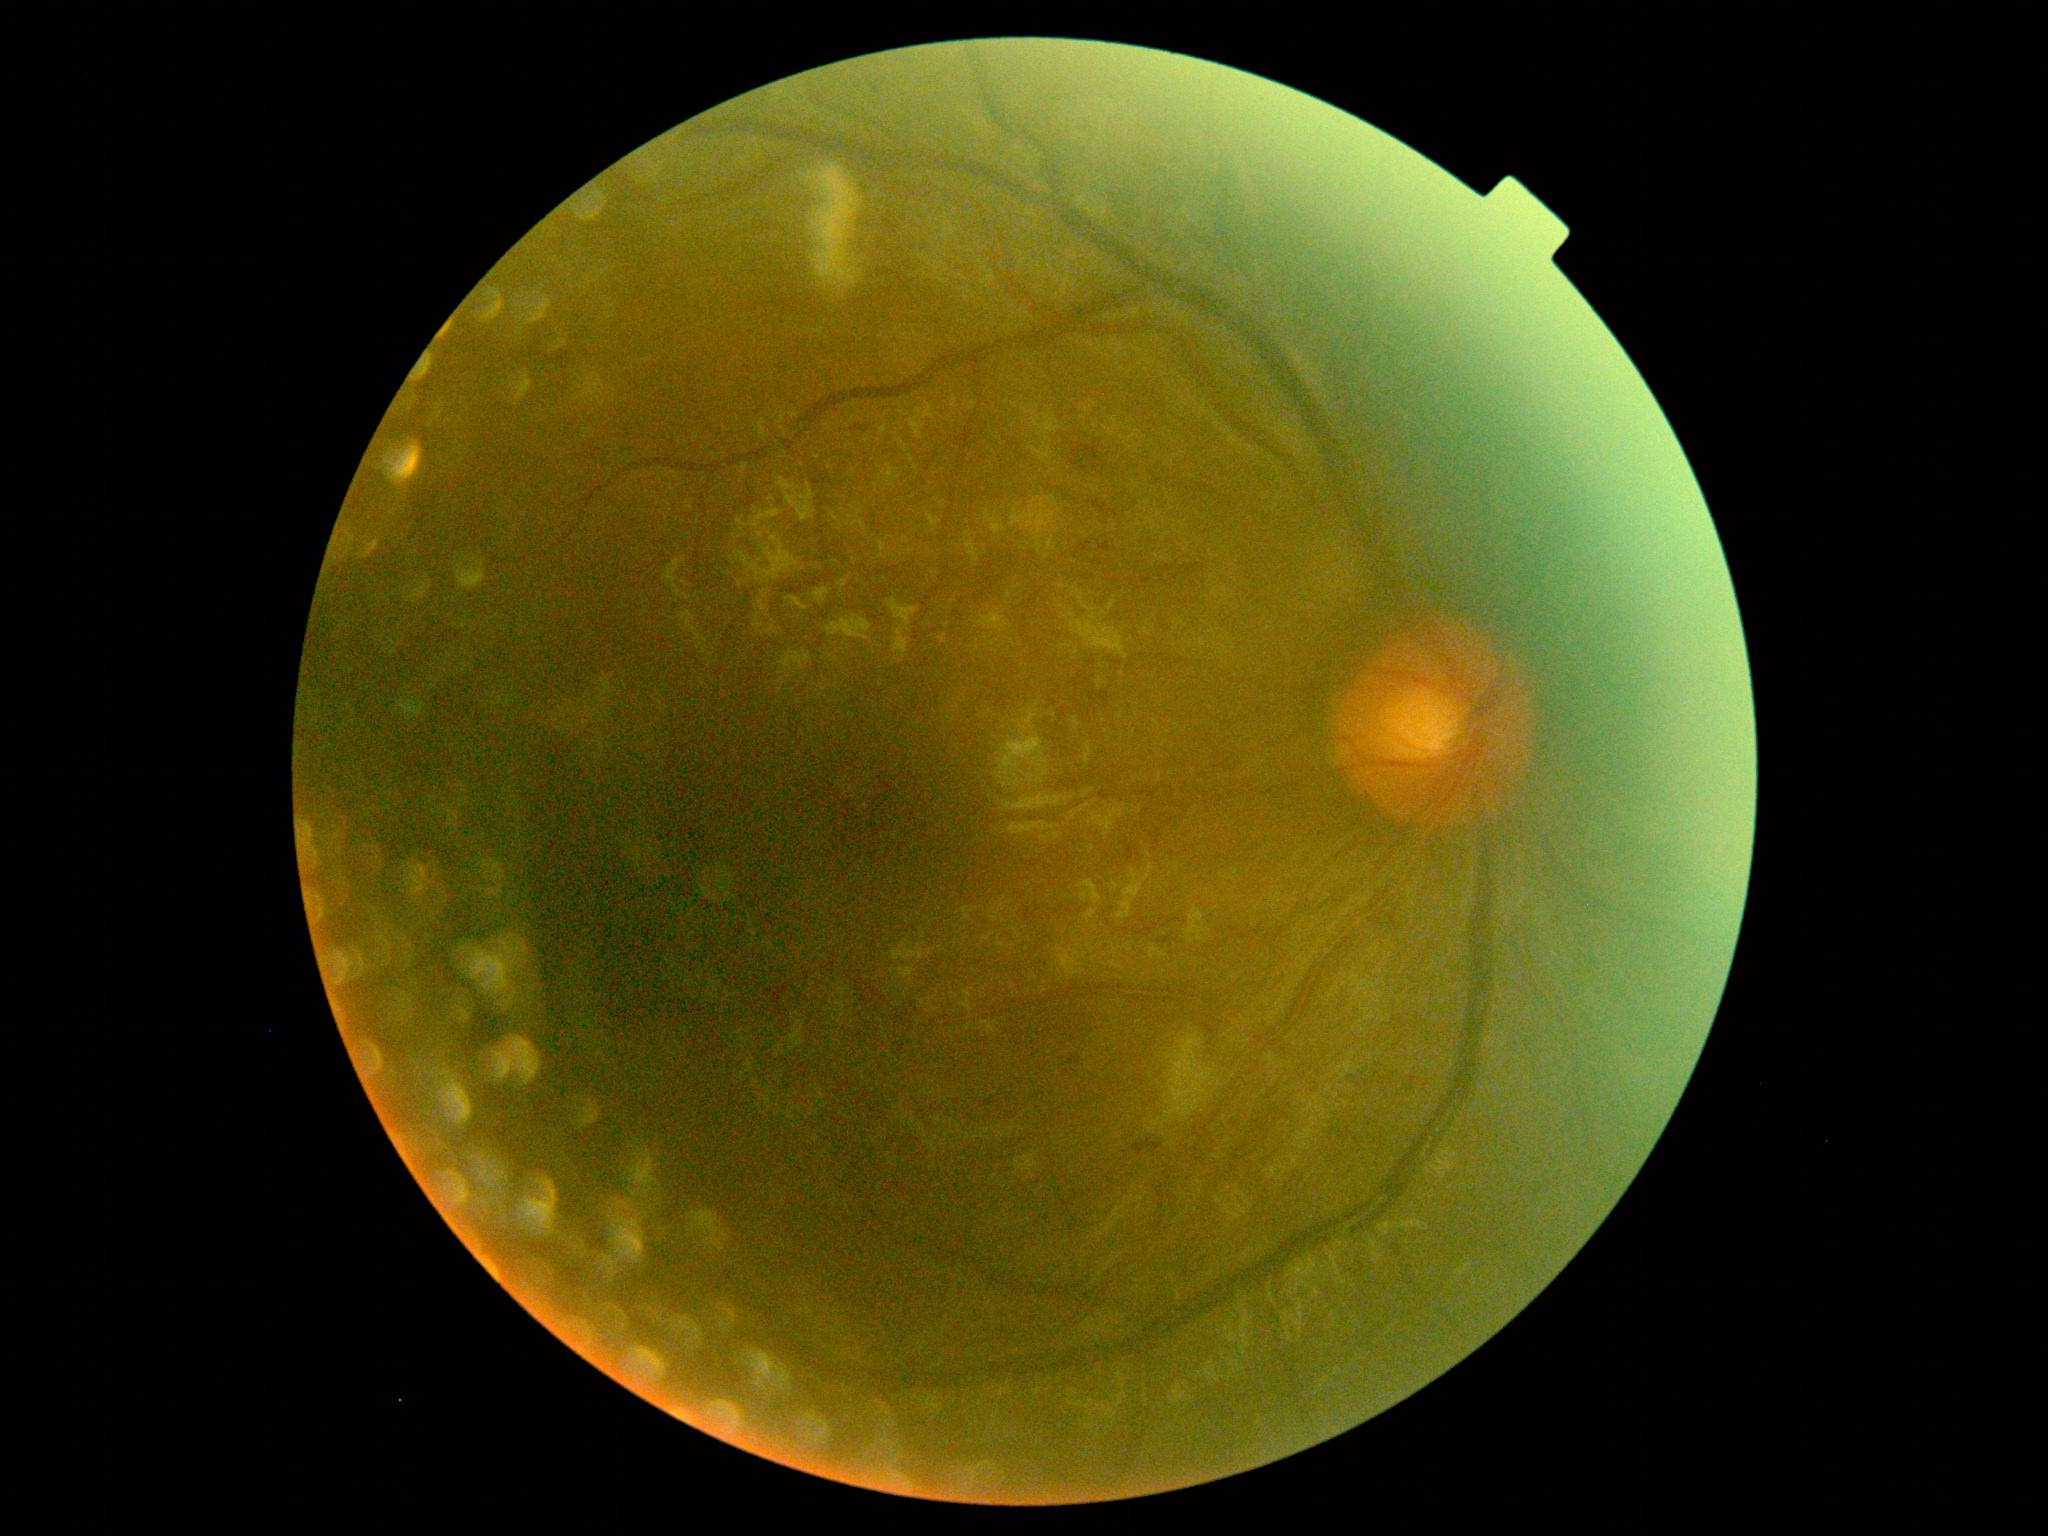 {"dr_grade": "grade 2 (moderate NPDR)", "dr_category": "non-proliferative diabetic retinopathy"}